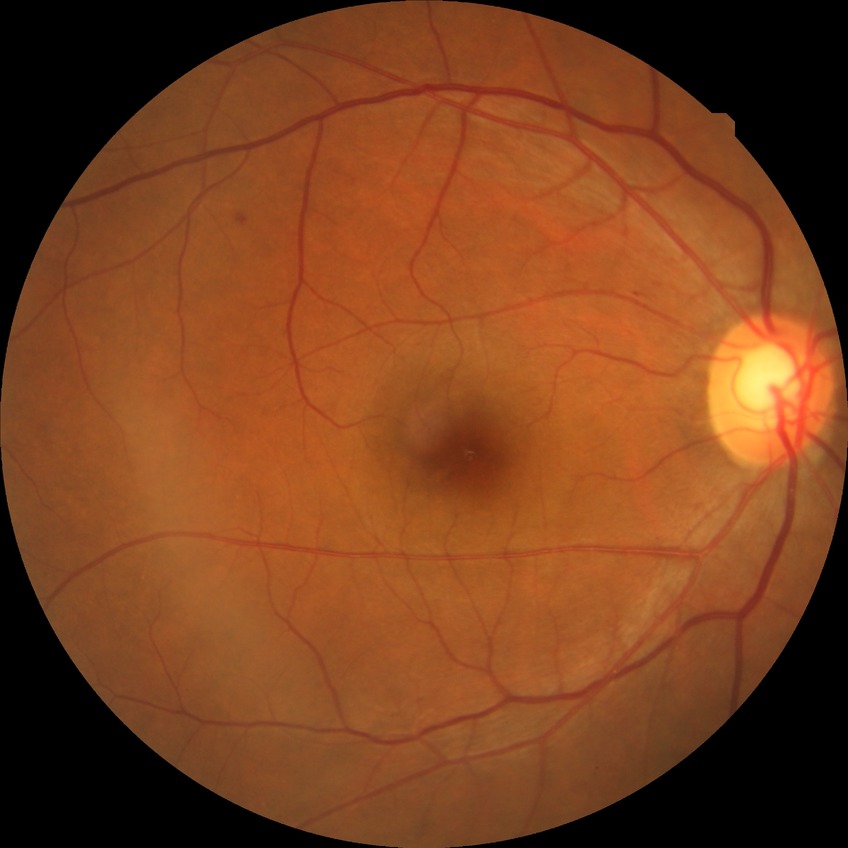

Davis stage: SDR.
The retinopathy is classified as non-proliferative diabetic retinopathy.